Retinal fundus photograph, 45° FOV, 2352x1568 — 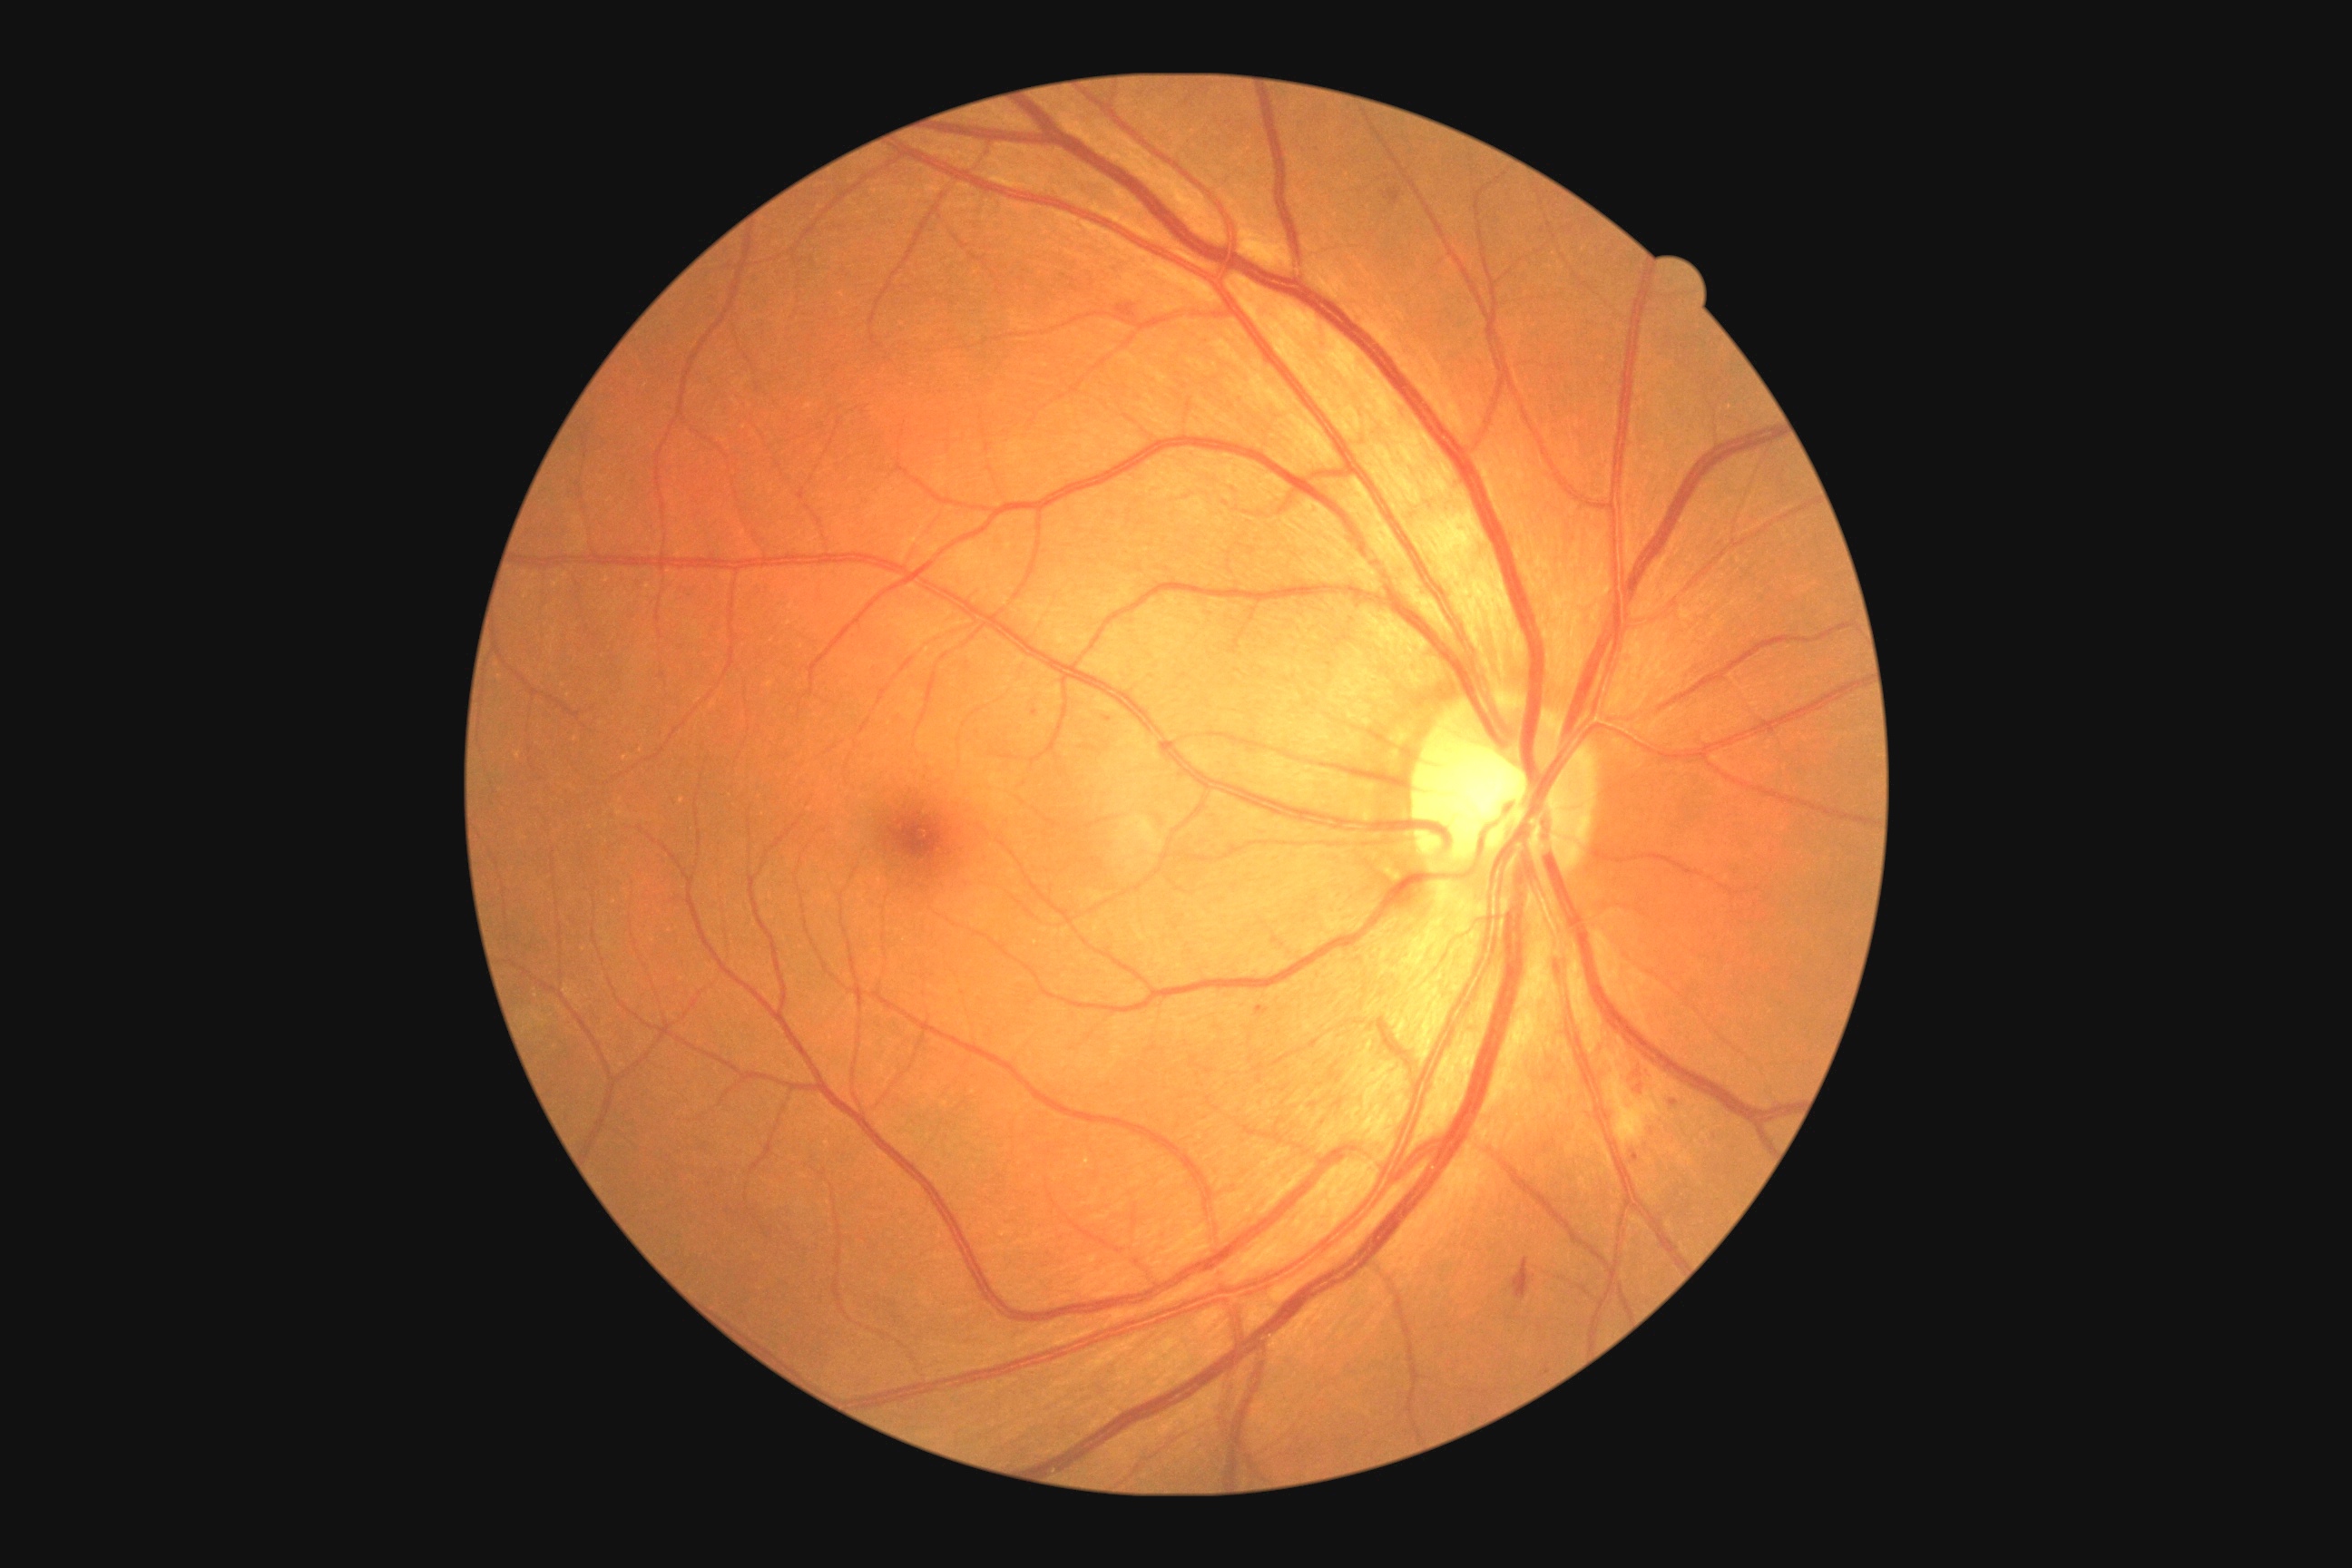 Diabetic retinopathy (DR) is moderate non-proliferative diabetic retinopathy (grade 2).